Image size 2228x1652. 50-degree field of view
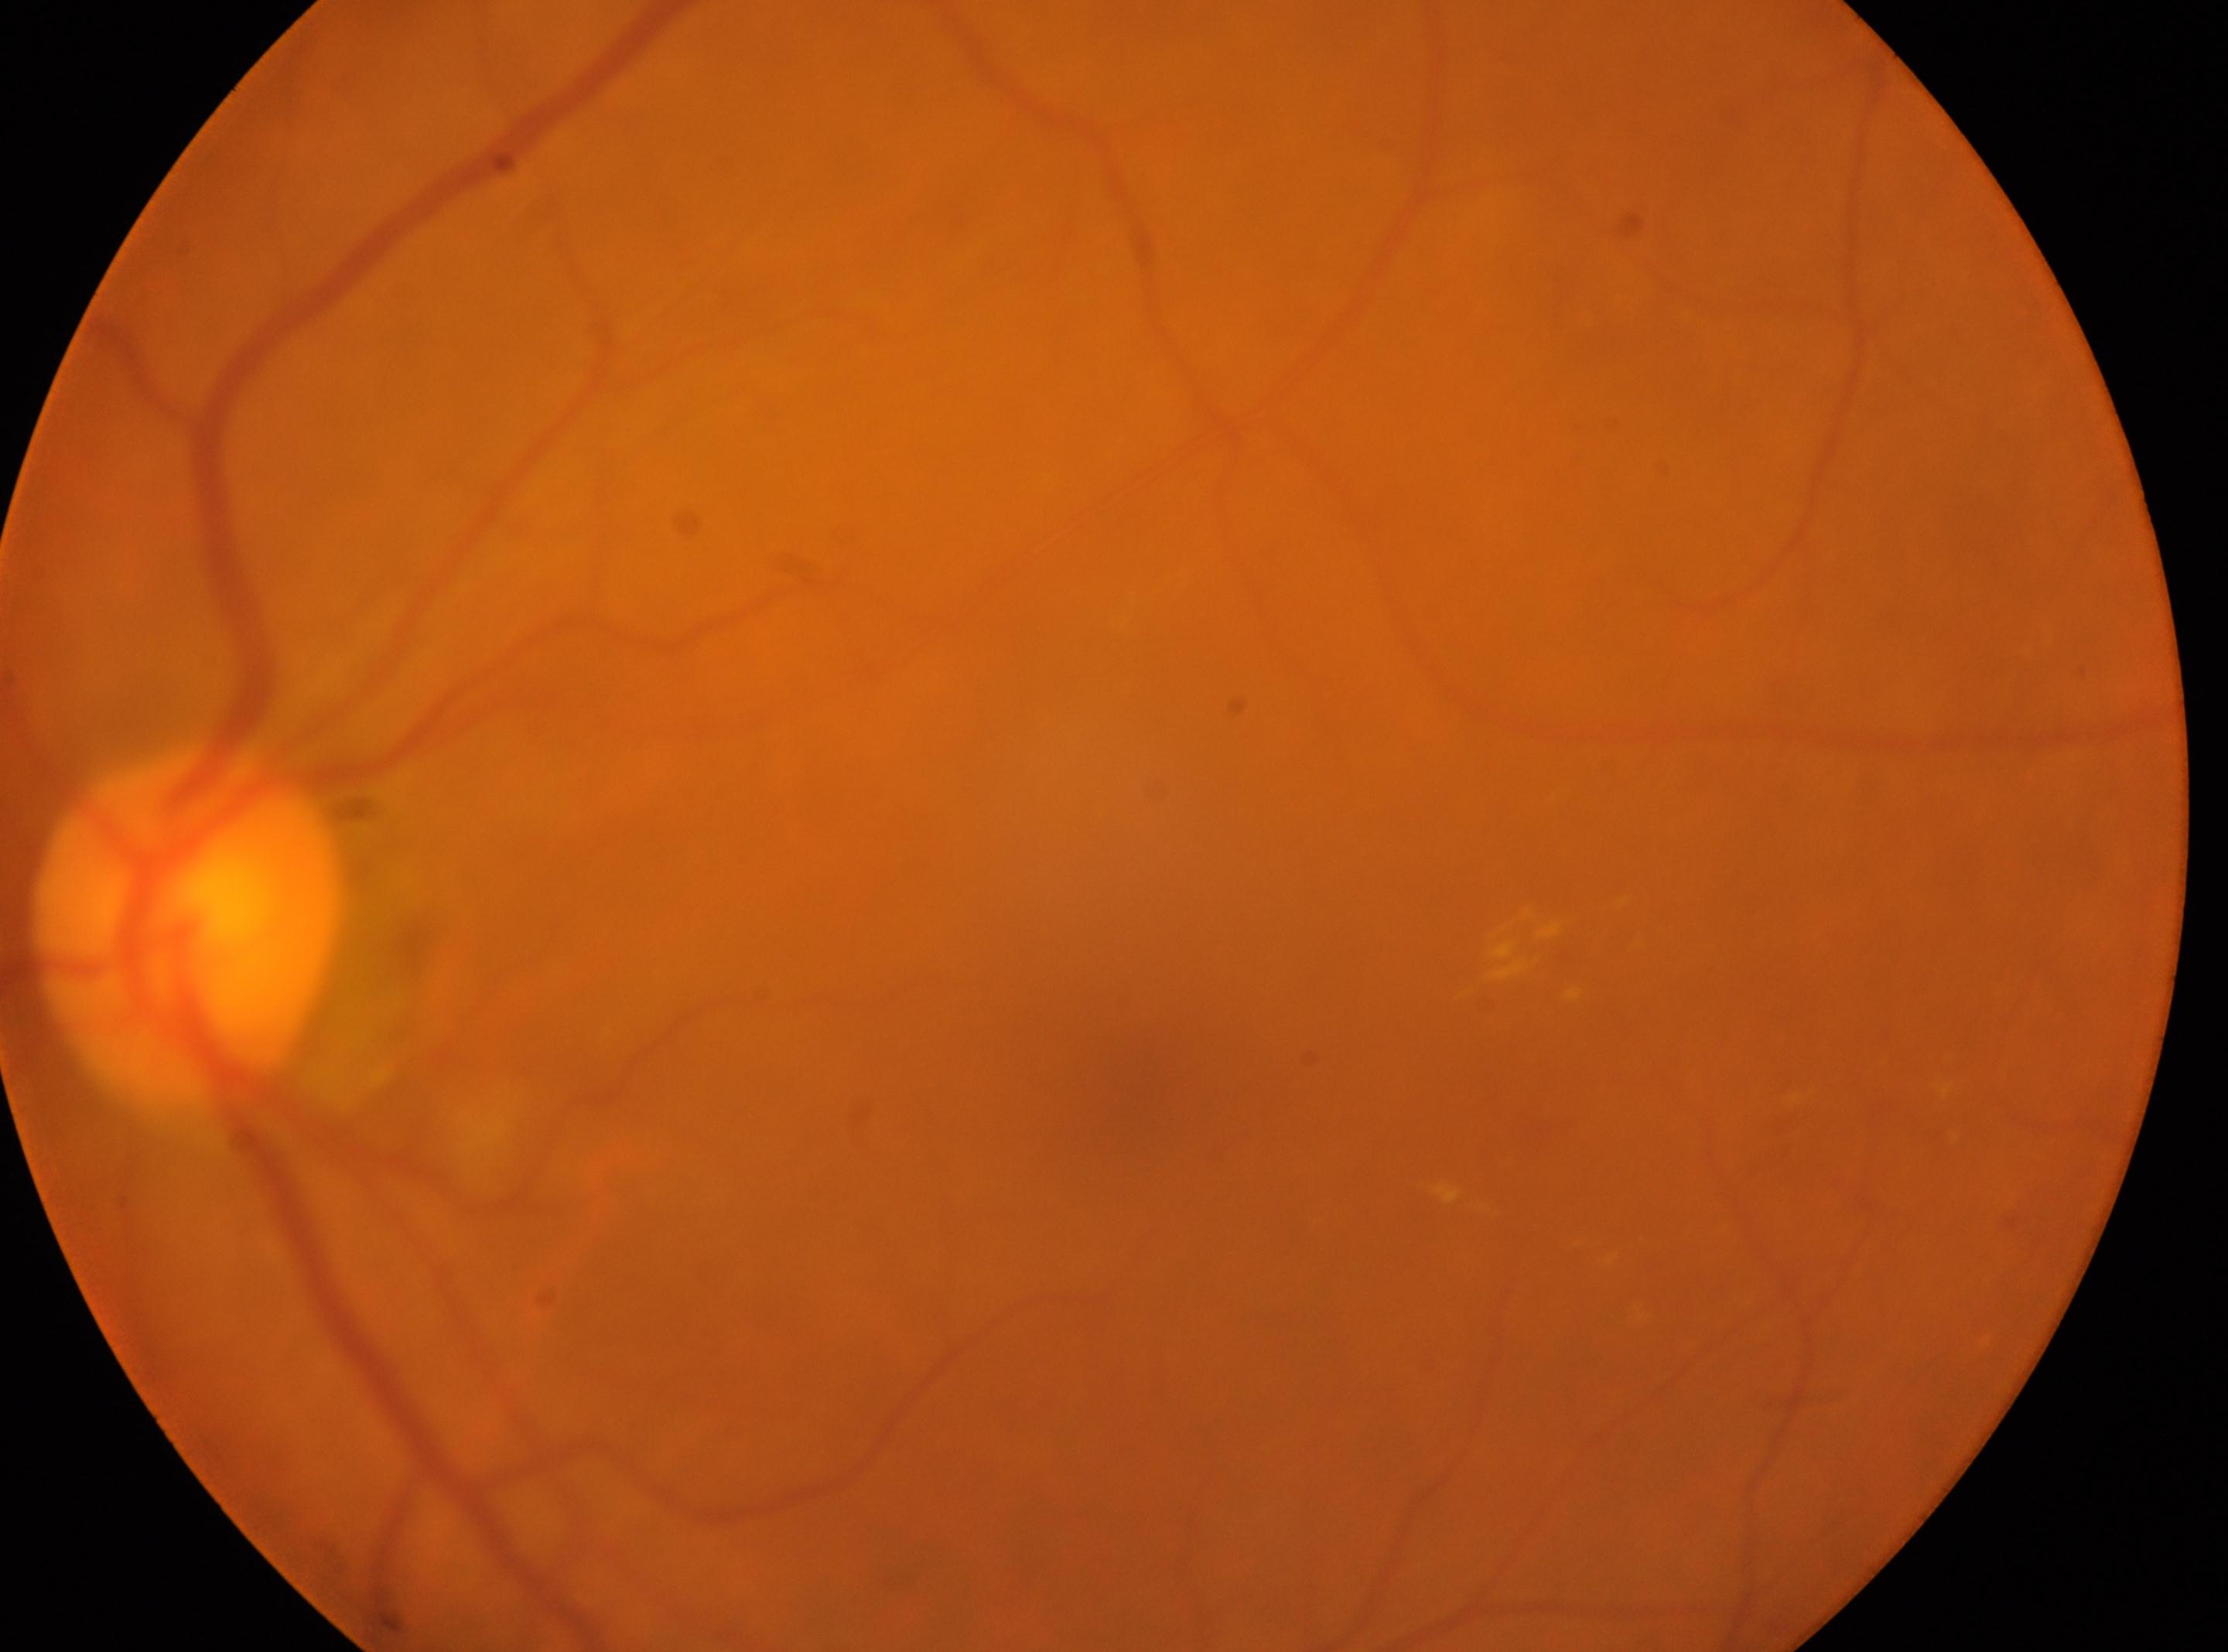

Annotations:
- optic disc center · x=186, y=928
- diabetic retinopathy (DR) · grade 2 (moderate NPDR) — more than just microaneurysms but less than severe NPDR
- fovea centralis · x=1162, y=1100
- DR class · non-proliferative diabetic retinopathy
- laterality · left